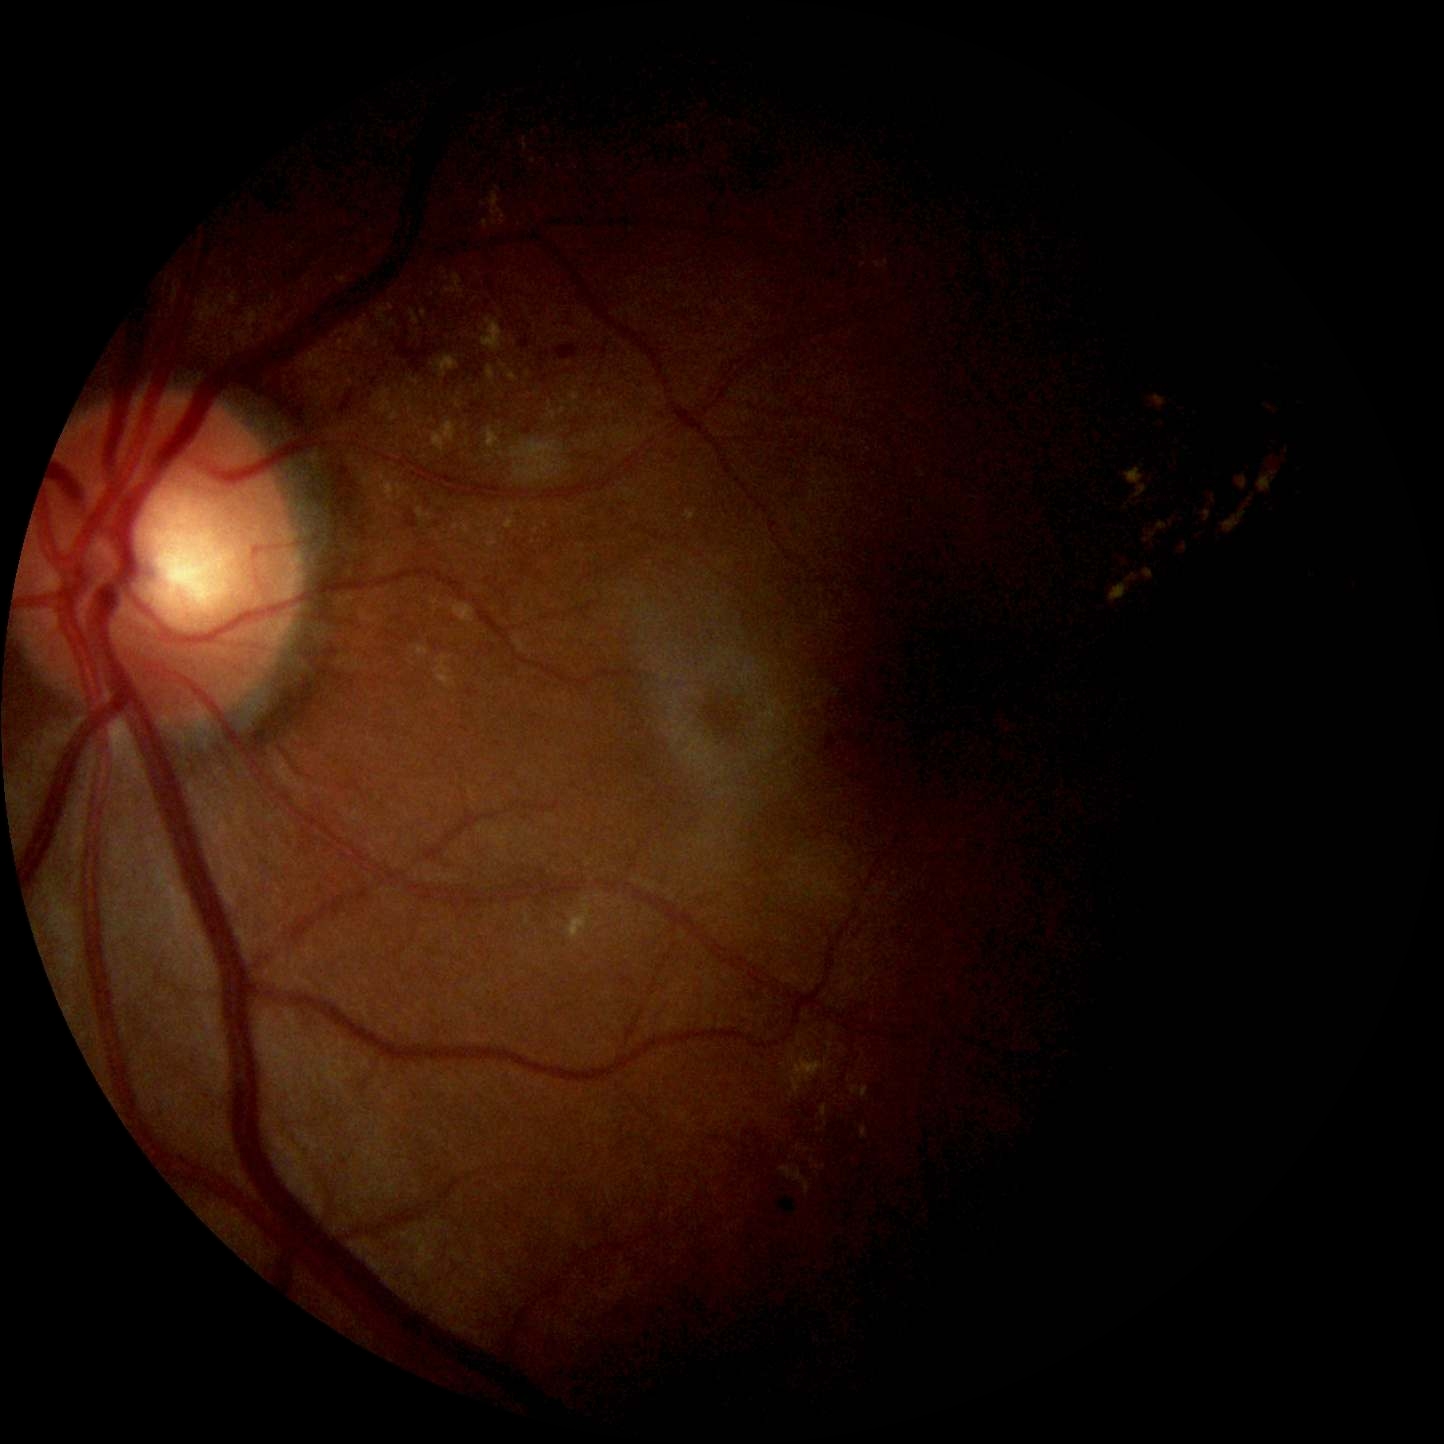
Diabetic retinopathy grade: moderate non-proliferative diabetic retinopathy (2).